DR severity per modified Davis staging:
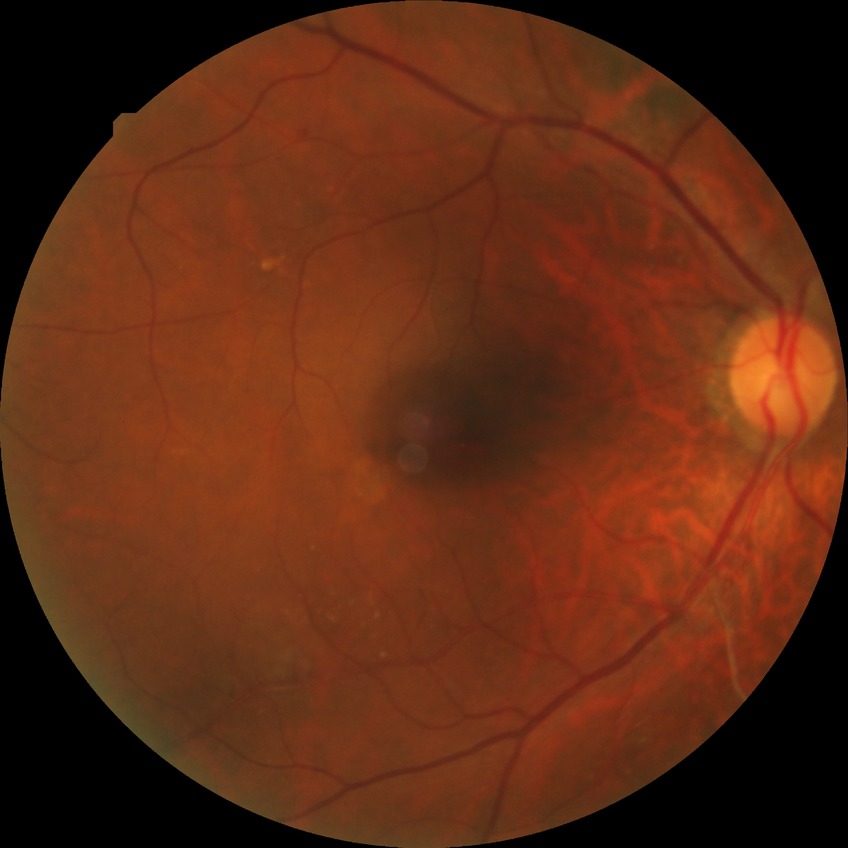

Disease class: non-proliferative diabetic retinopathy. Diabetic retinopathy (DR): PPDR (pre-proliferative diabetic retinopathy).